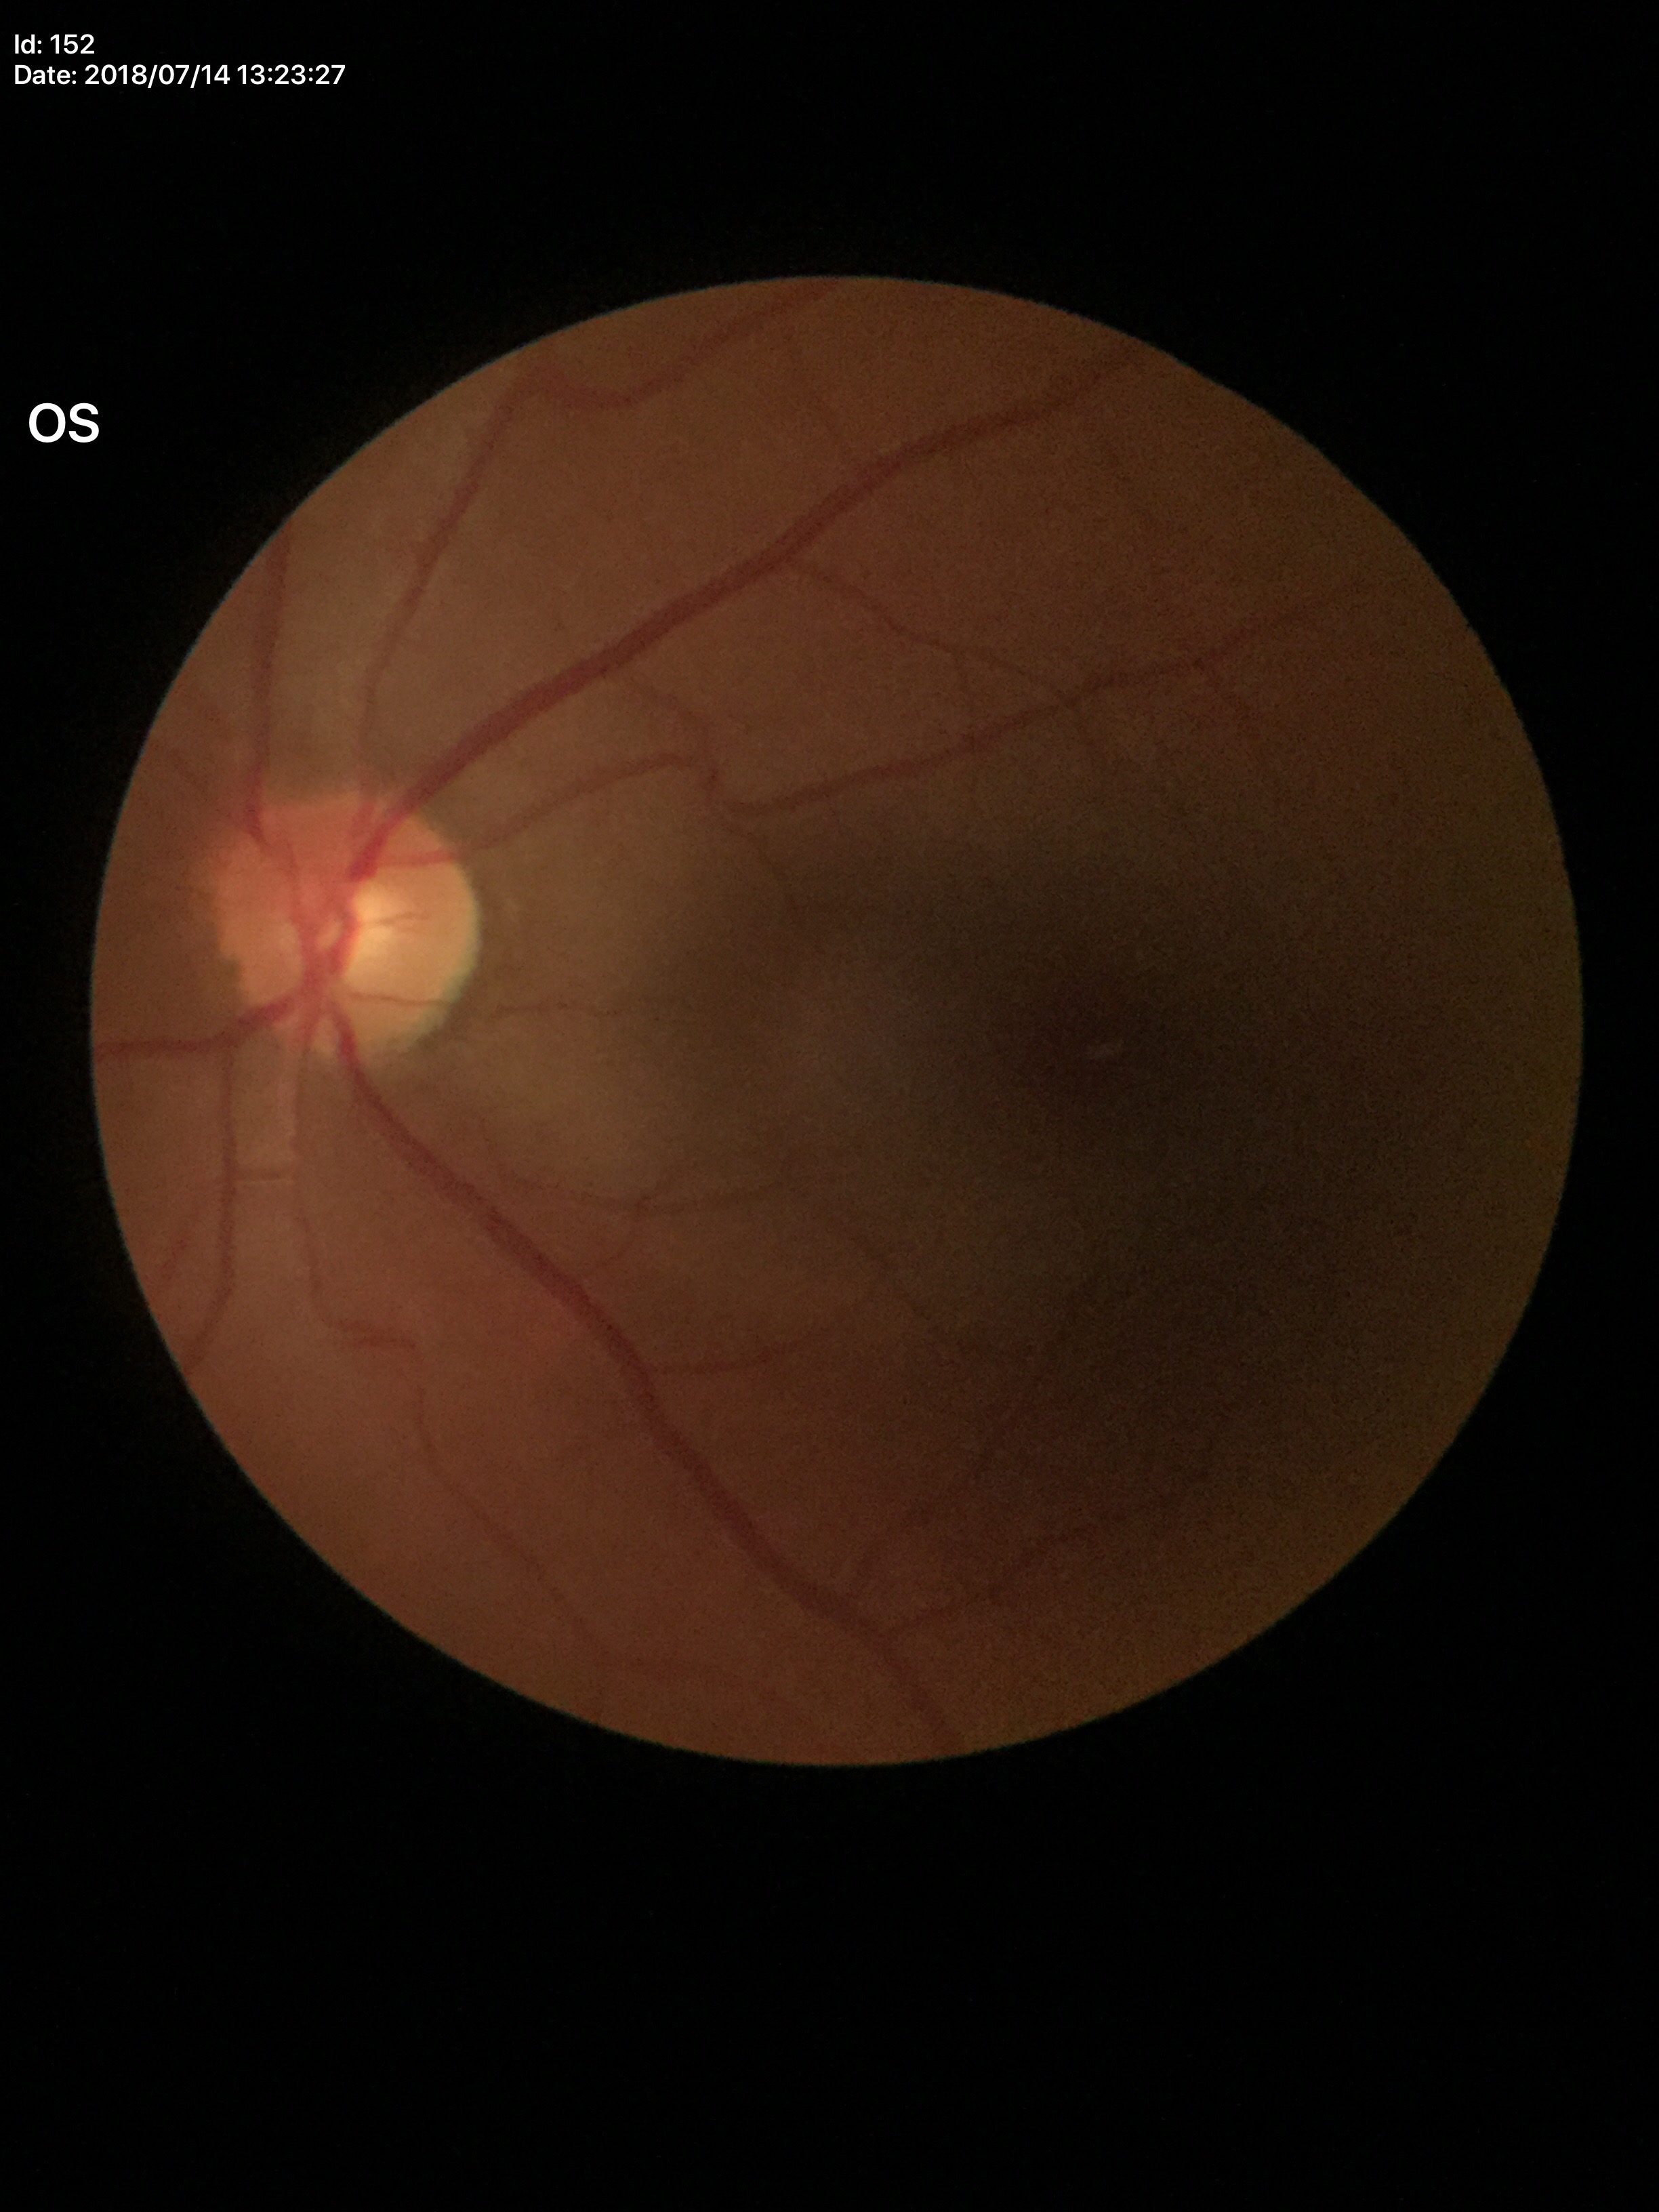

Not suspicious for glaucoma (all 5 graders called normal).
Vertical CDR (VCDR) of 0.50.
Horizontal cup-to-disc ratio (HCDR) of 0.48.